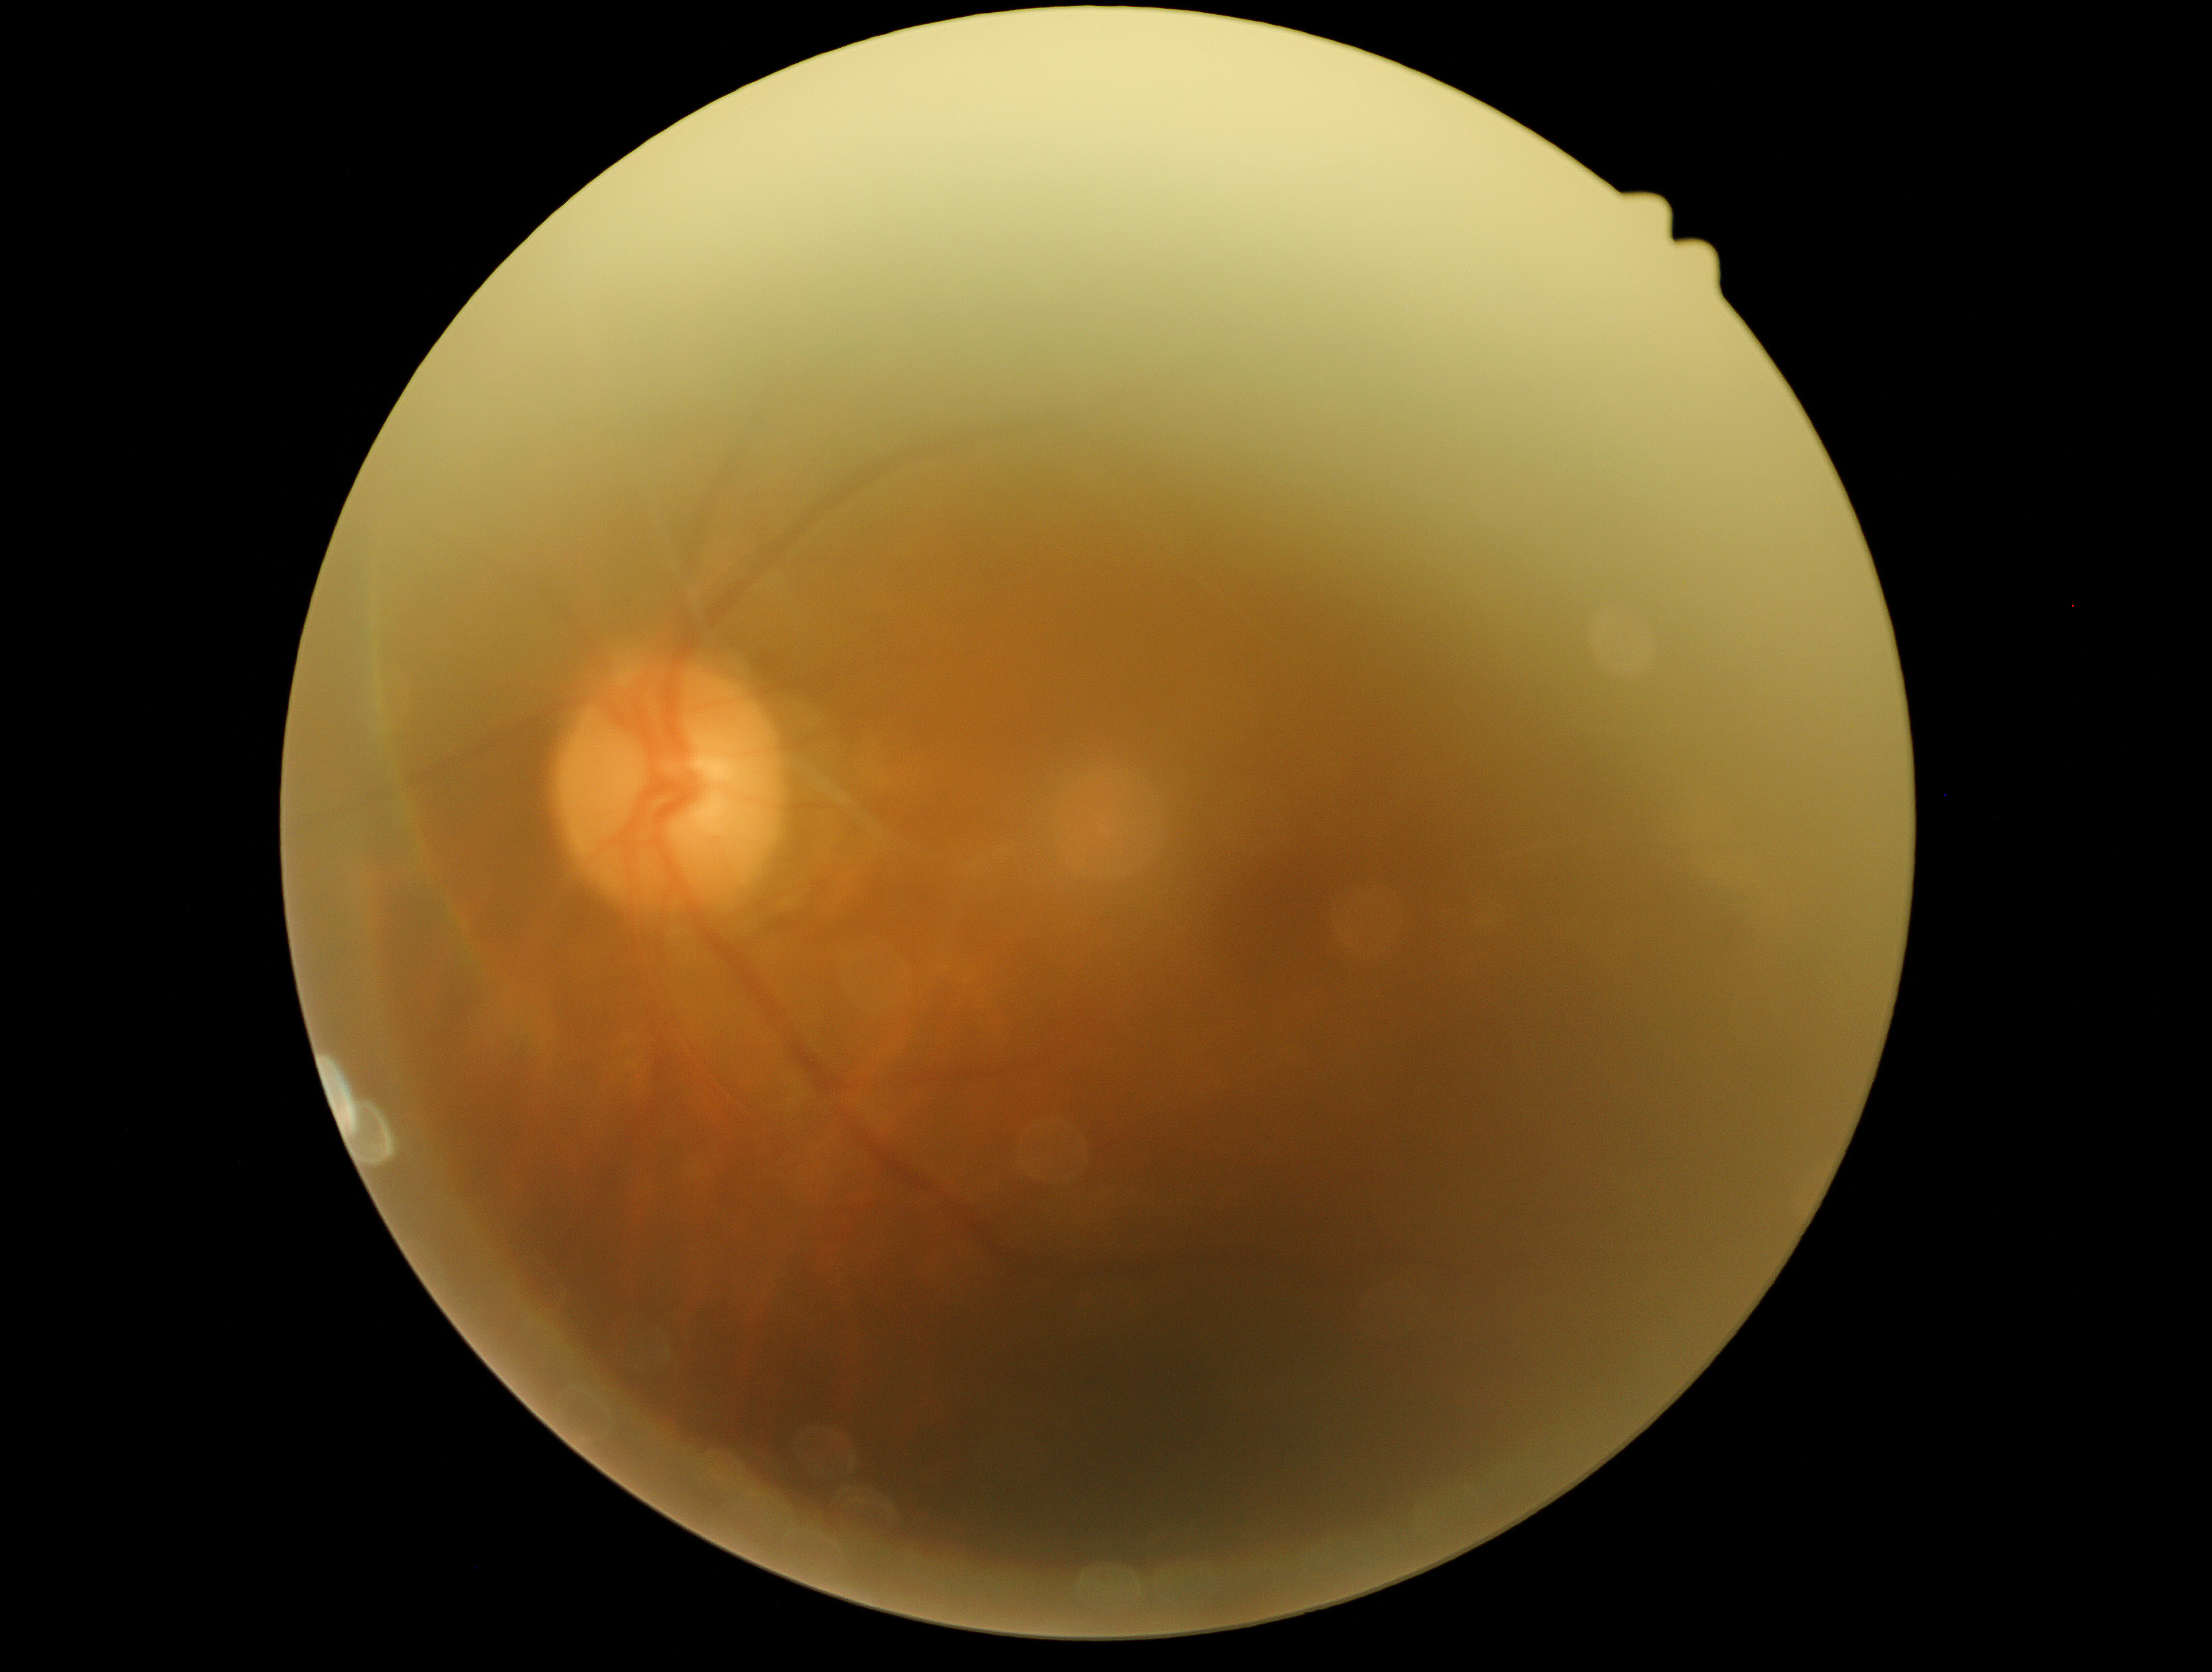
Diabetic retinopathy (DR) is no apparent retinopathy (grade 0). No diabetic retinal disease findings.